640 by 480 pixels · pediatric retinal photograph (wide-field): 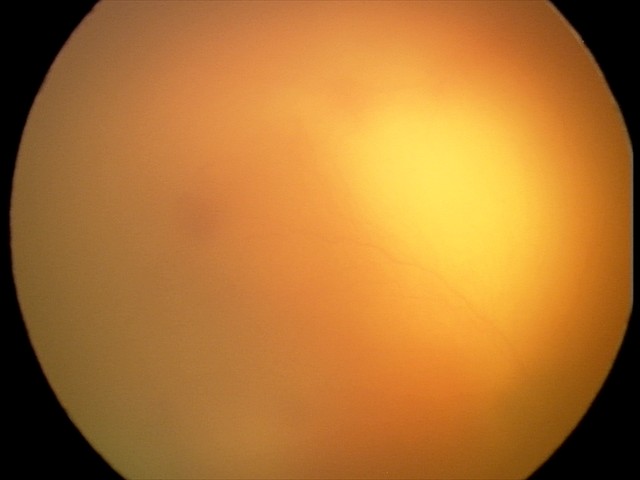

Plus disease present. From an examination with diagnosis of A-ROP (aggressive ROP).